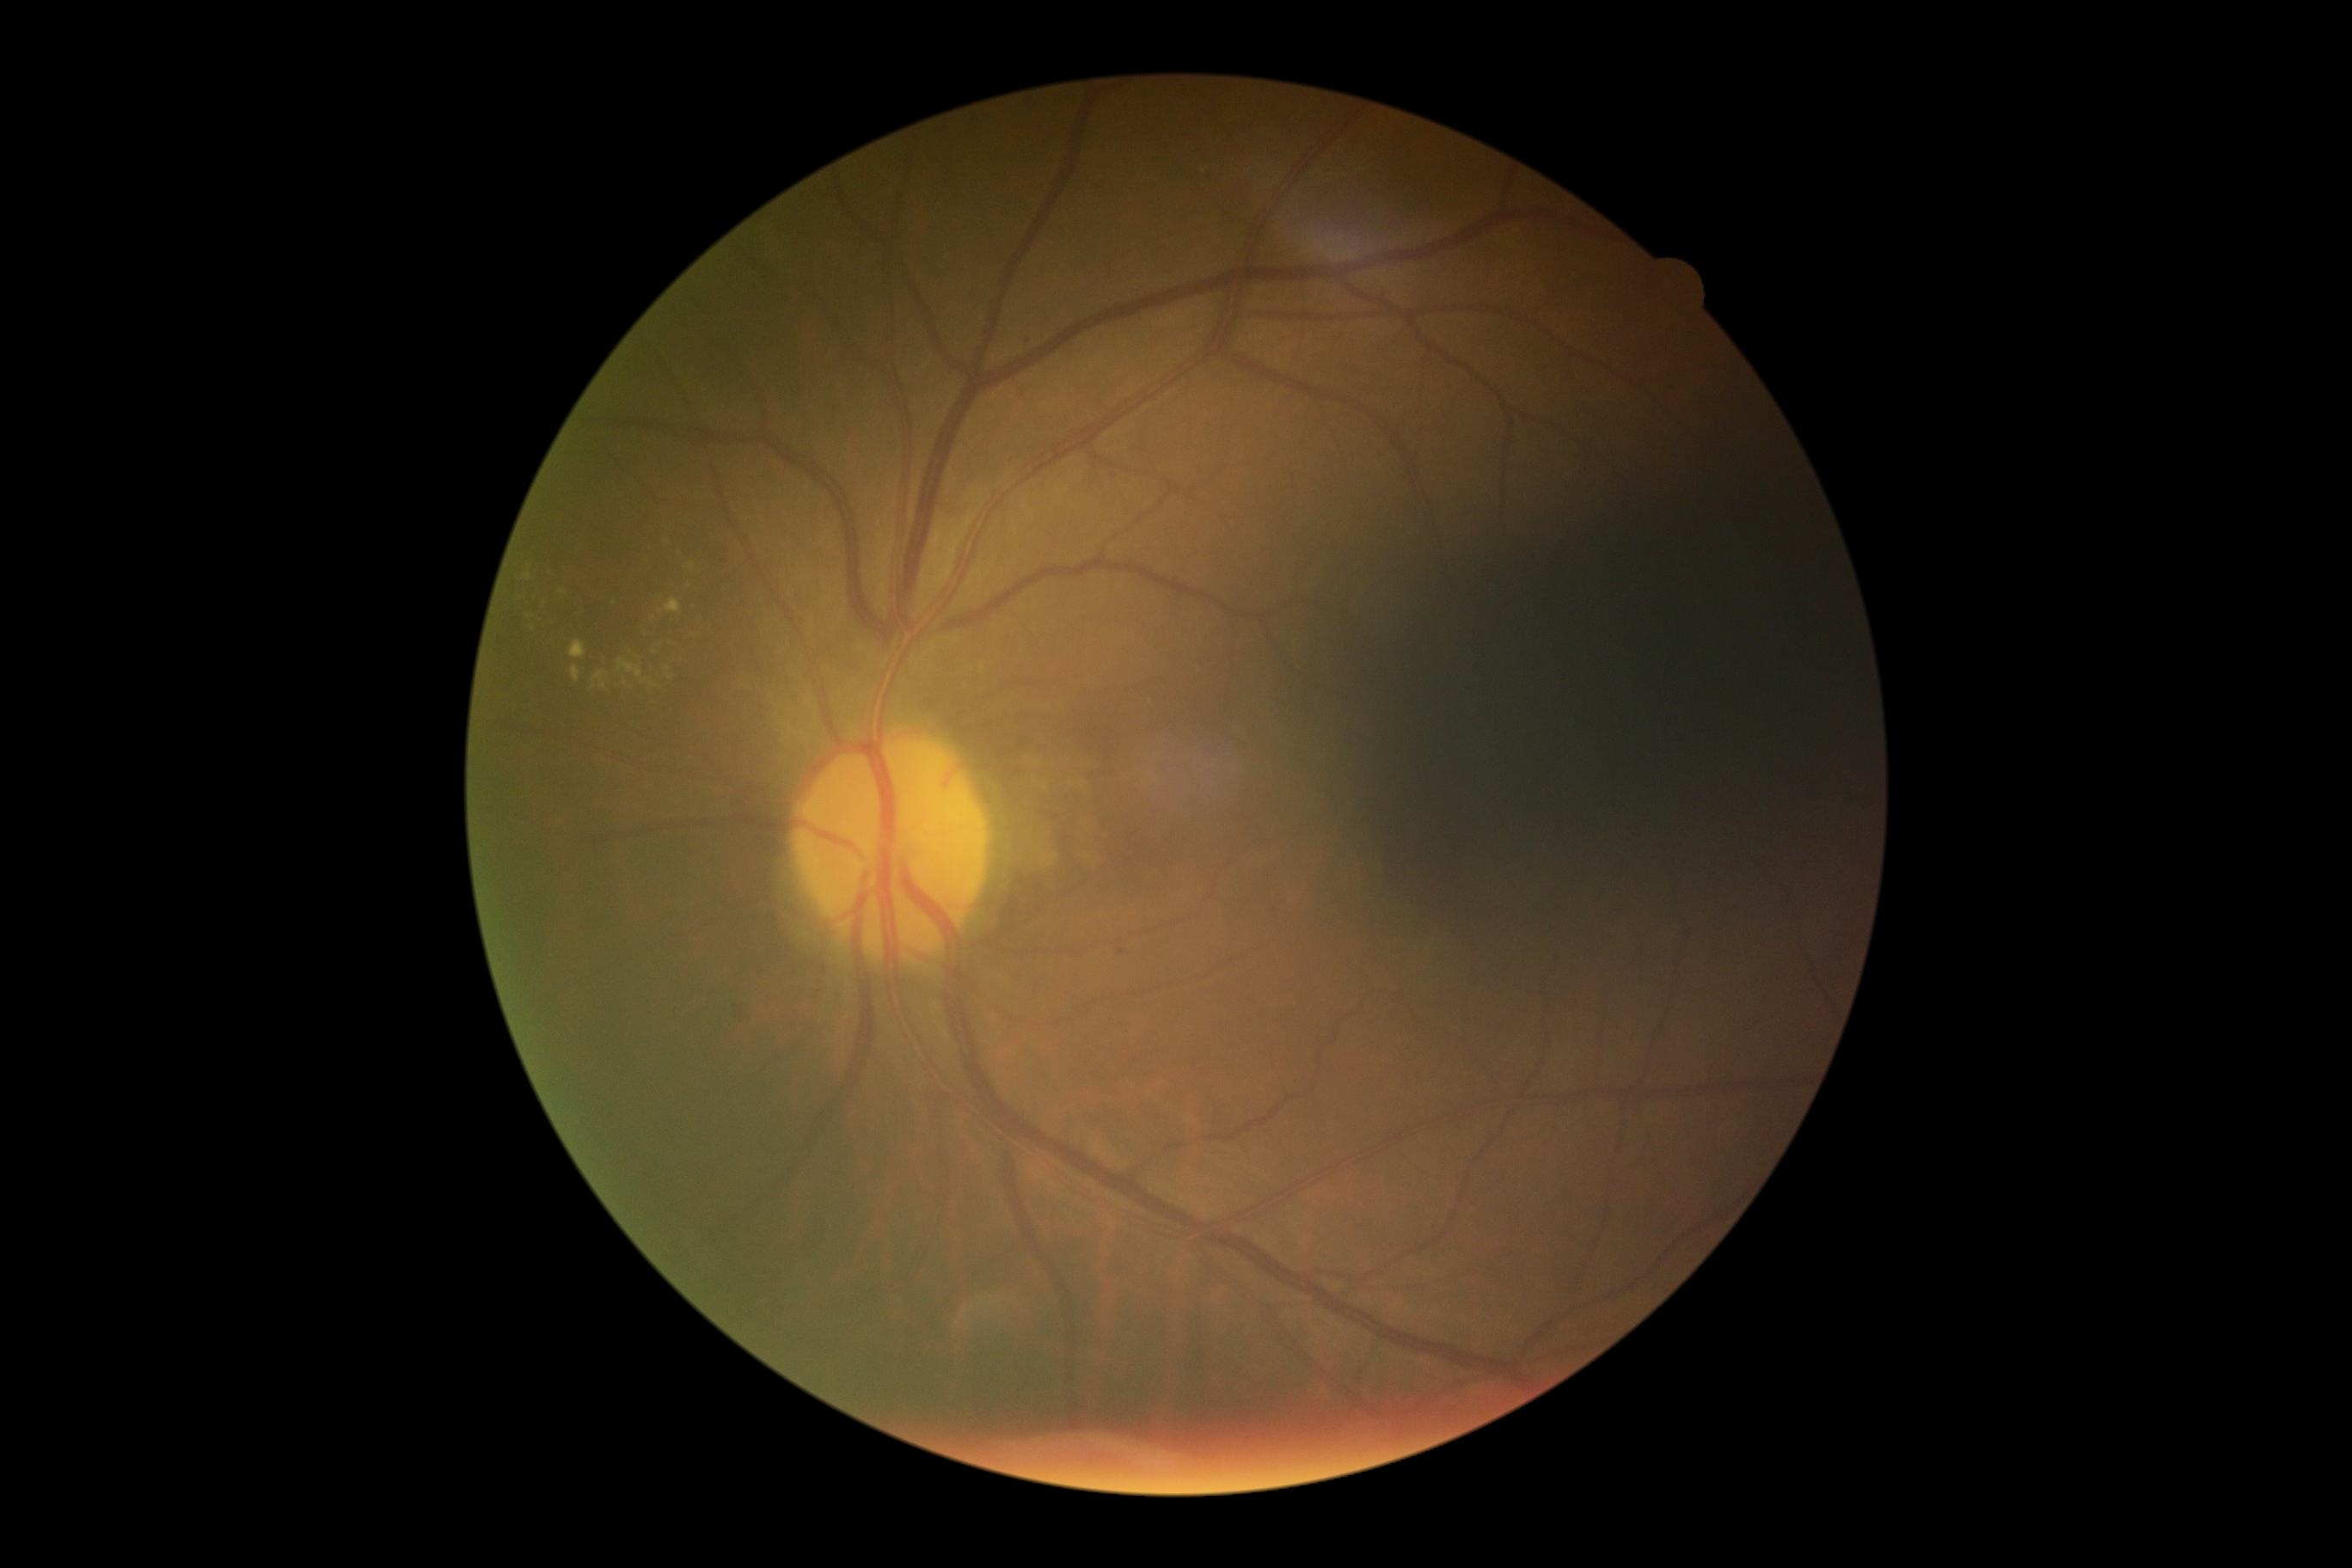

diabetic retinopathy (DR)=moderate non-proliferative diabetic retinopathy (grade 2).